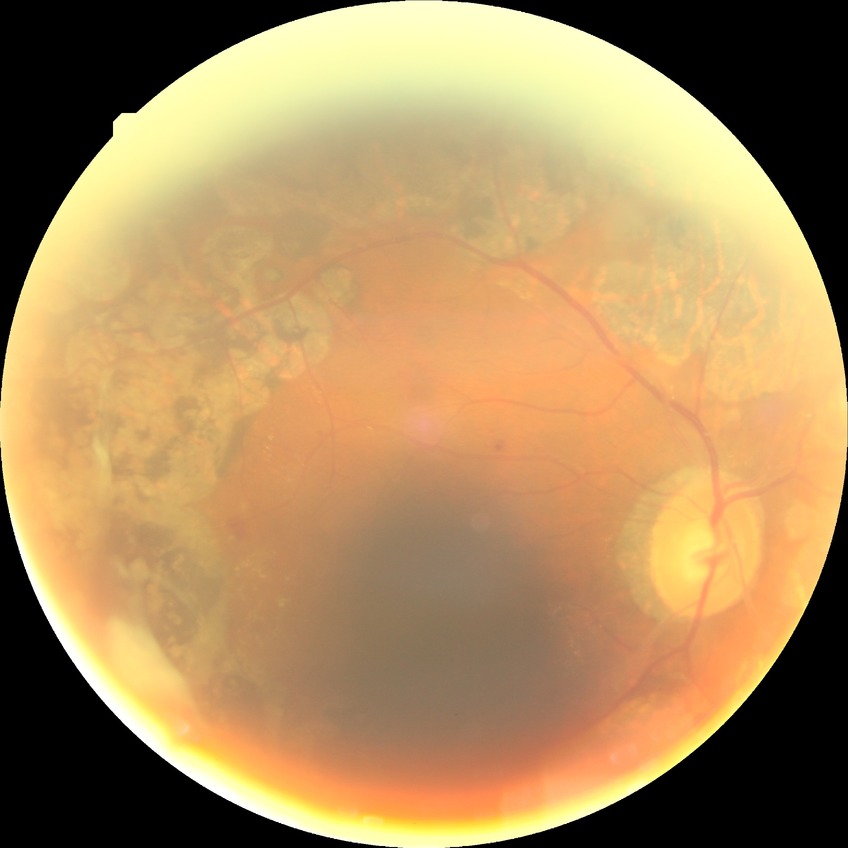 diabetic retinopathy grade@proliferative diabetic retinopathy.